FOV: 45 degrees.
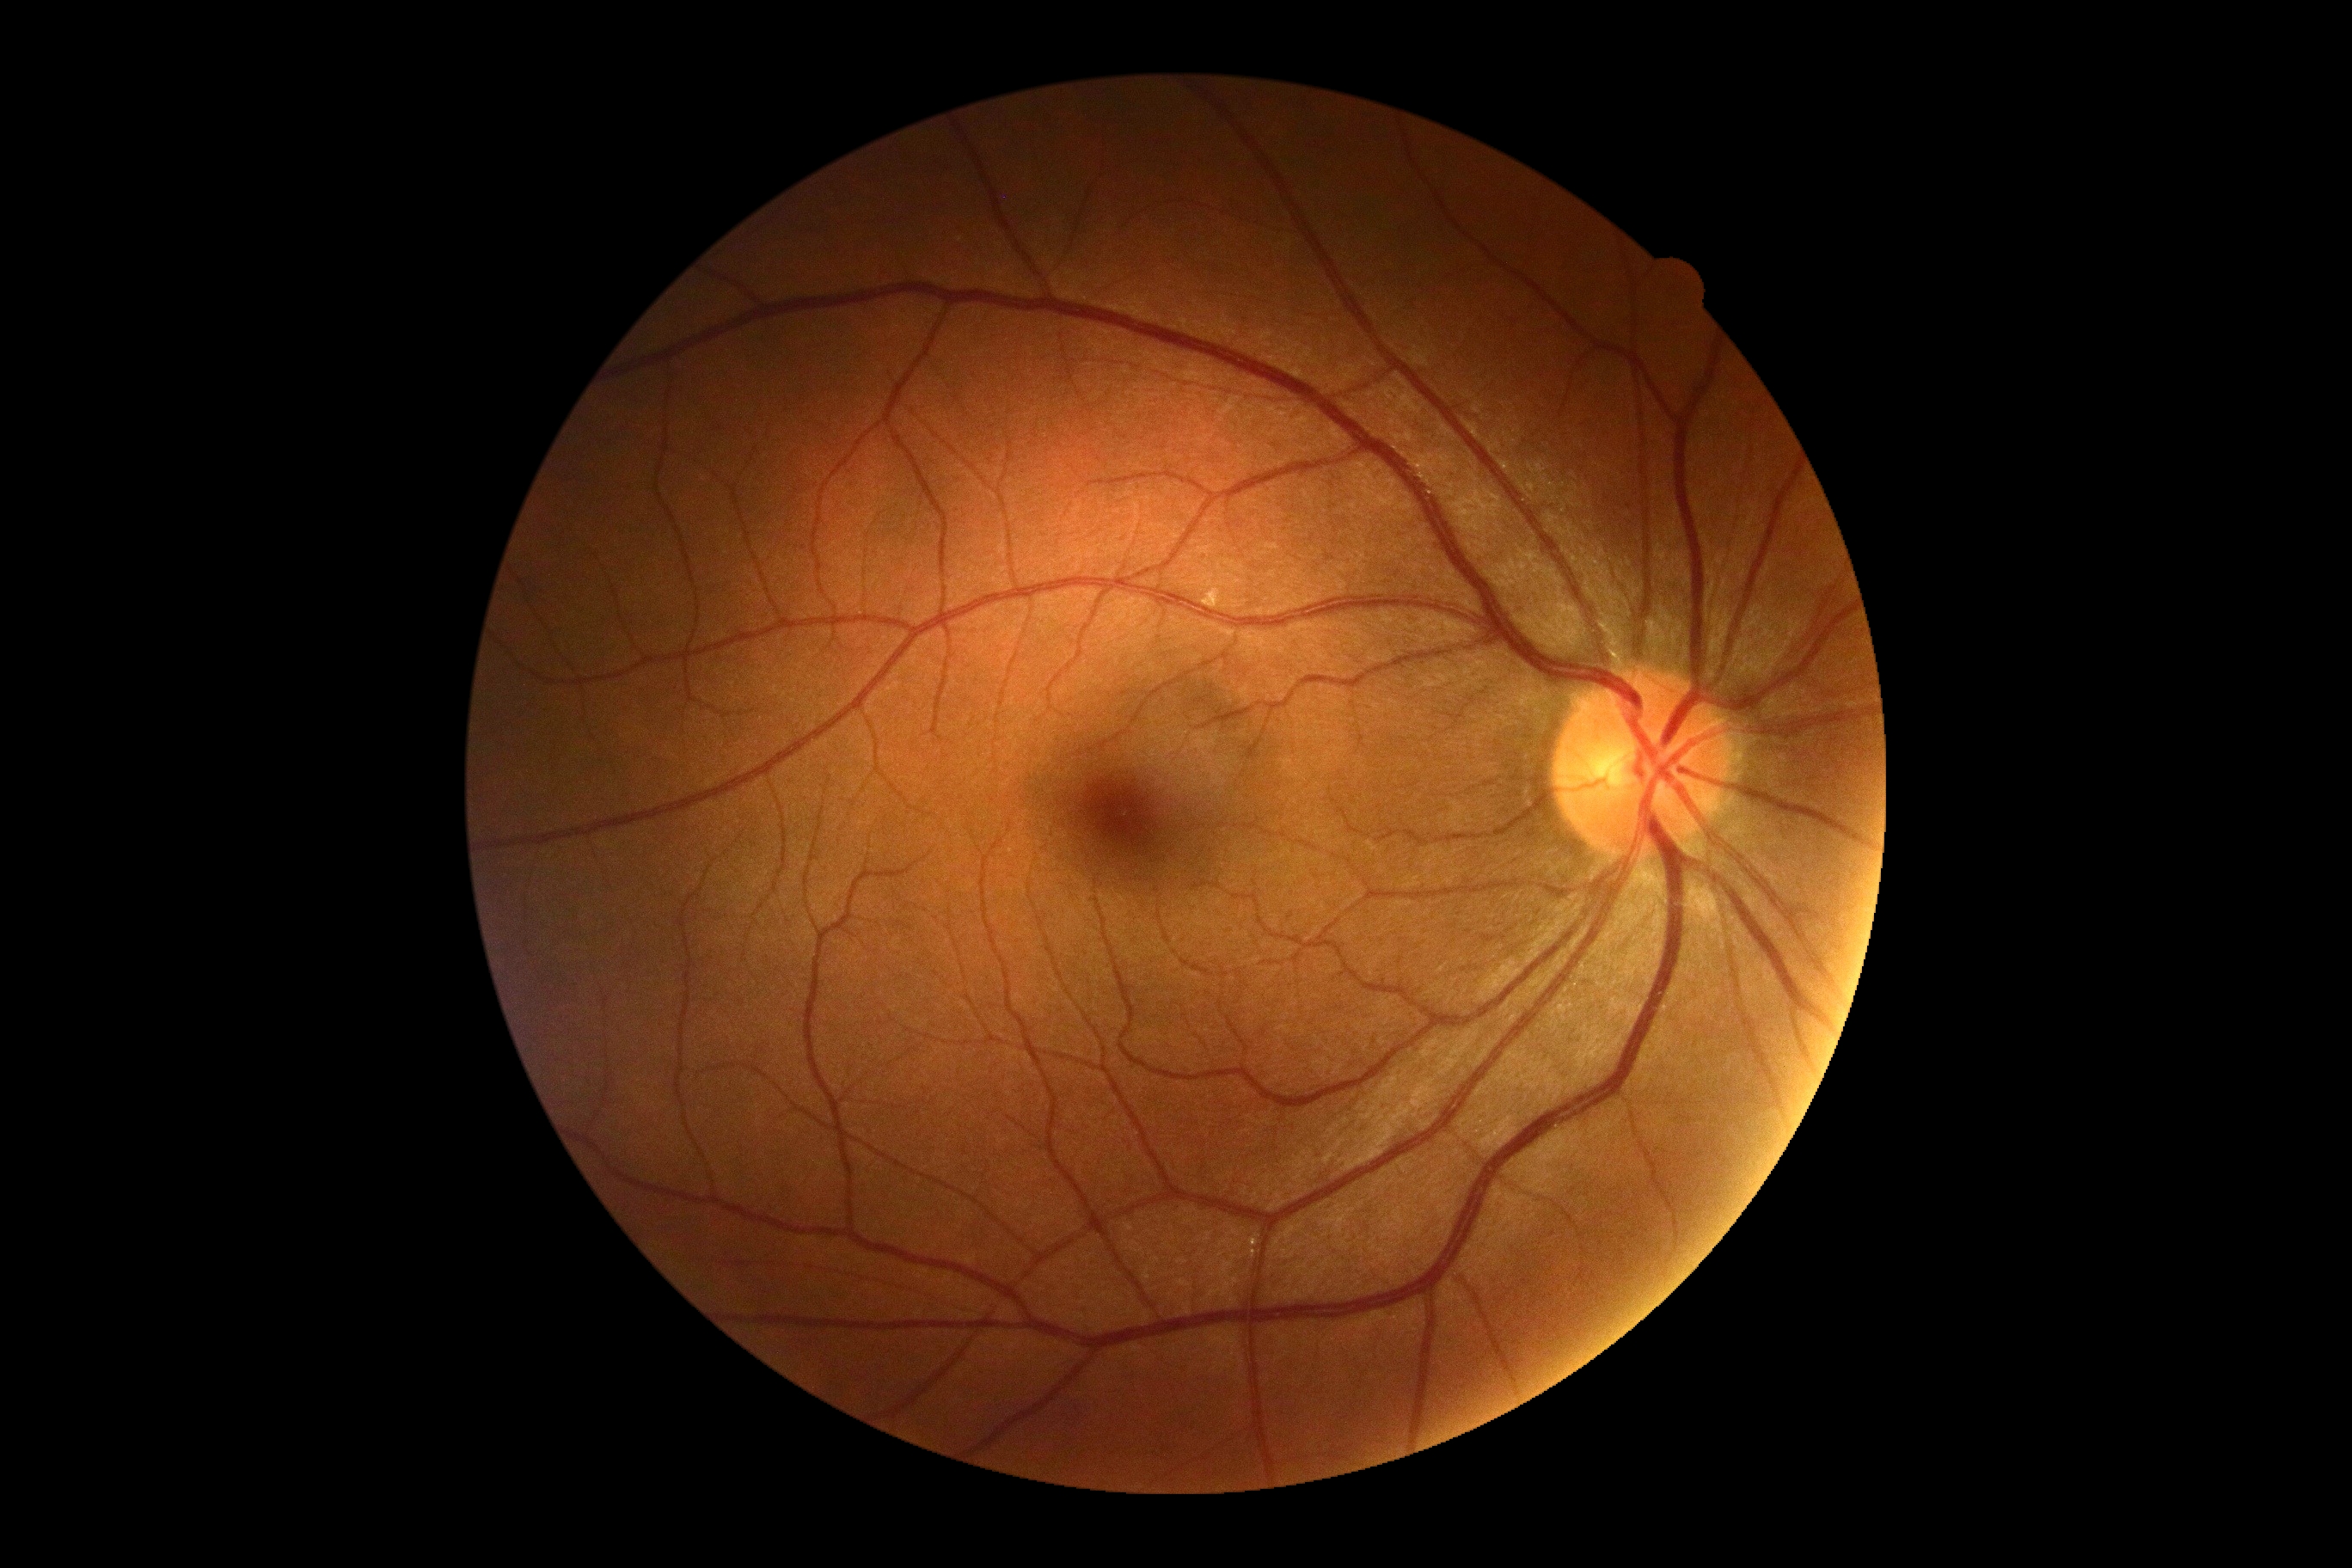
No DR findings. DR stage is grade 0 (no apparent retinopathy).